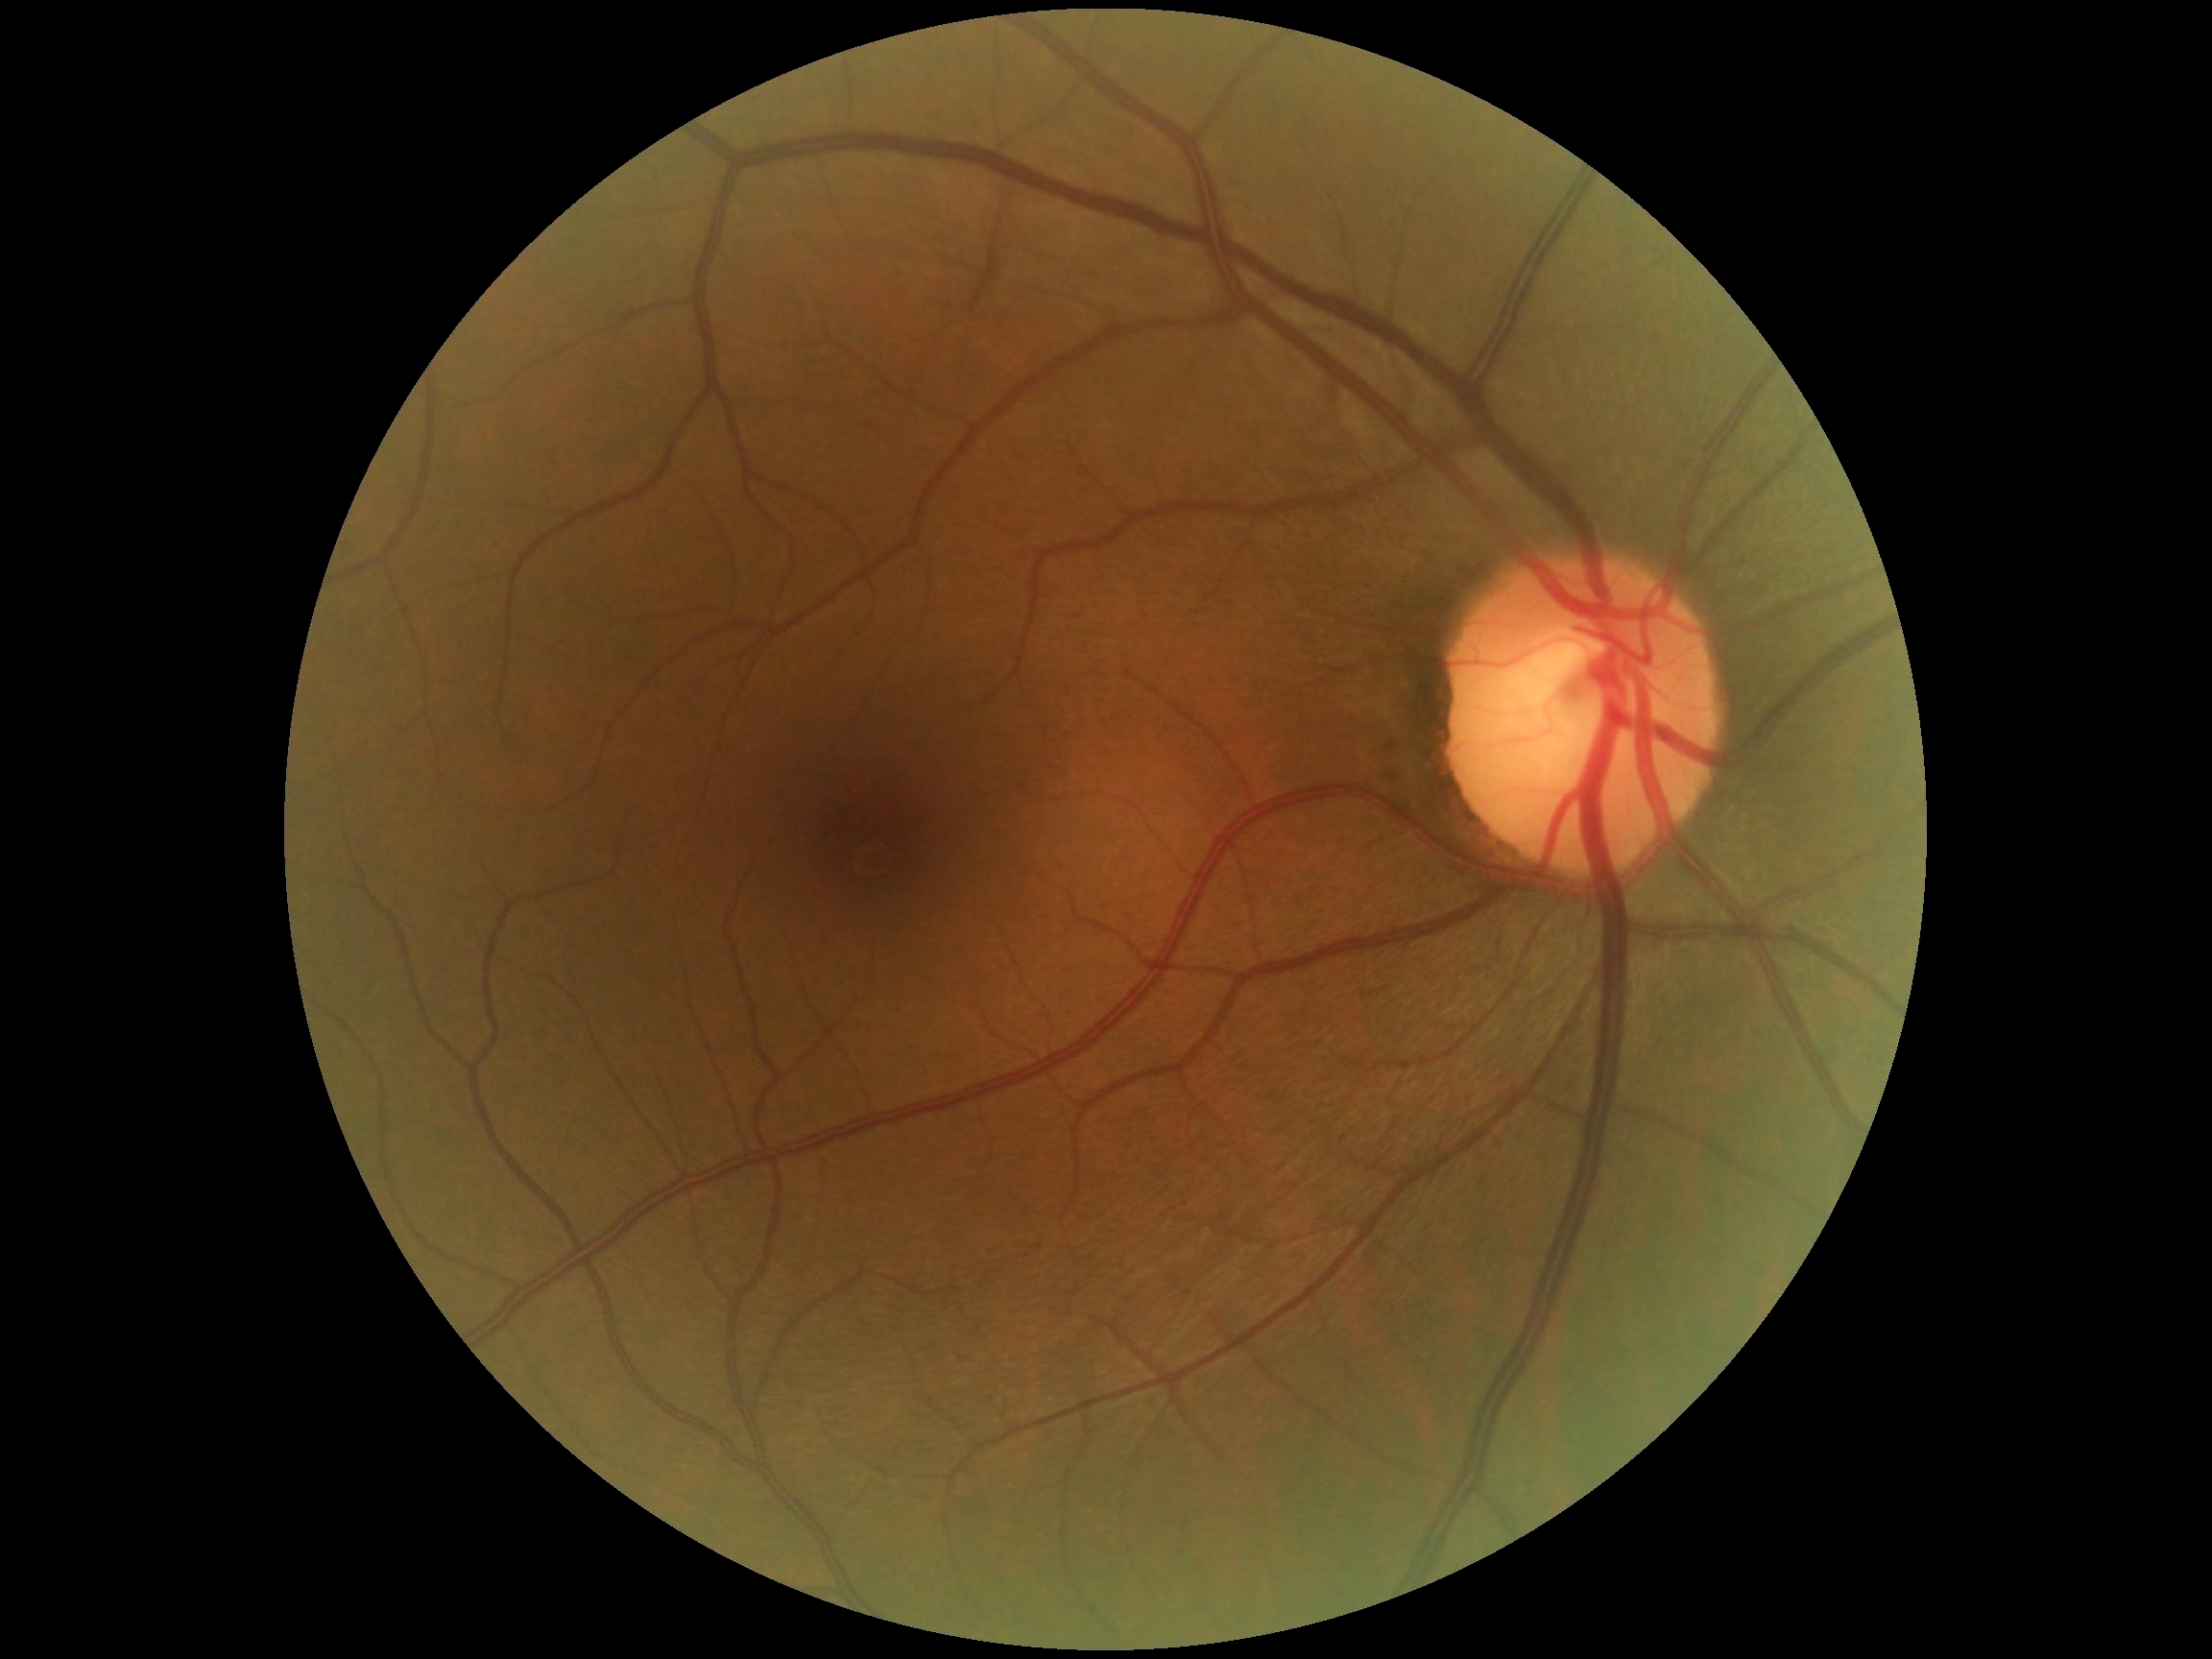
DR severity = grade 0 (no apparent retinopathy).